Wide-field fundus image from infant ROP screening:
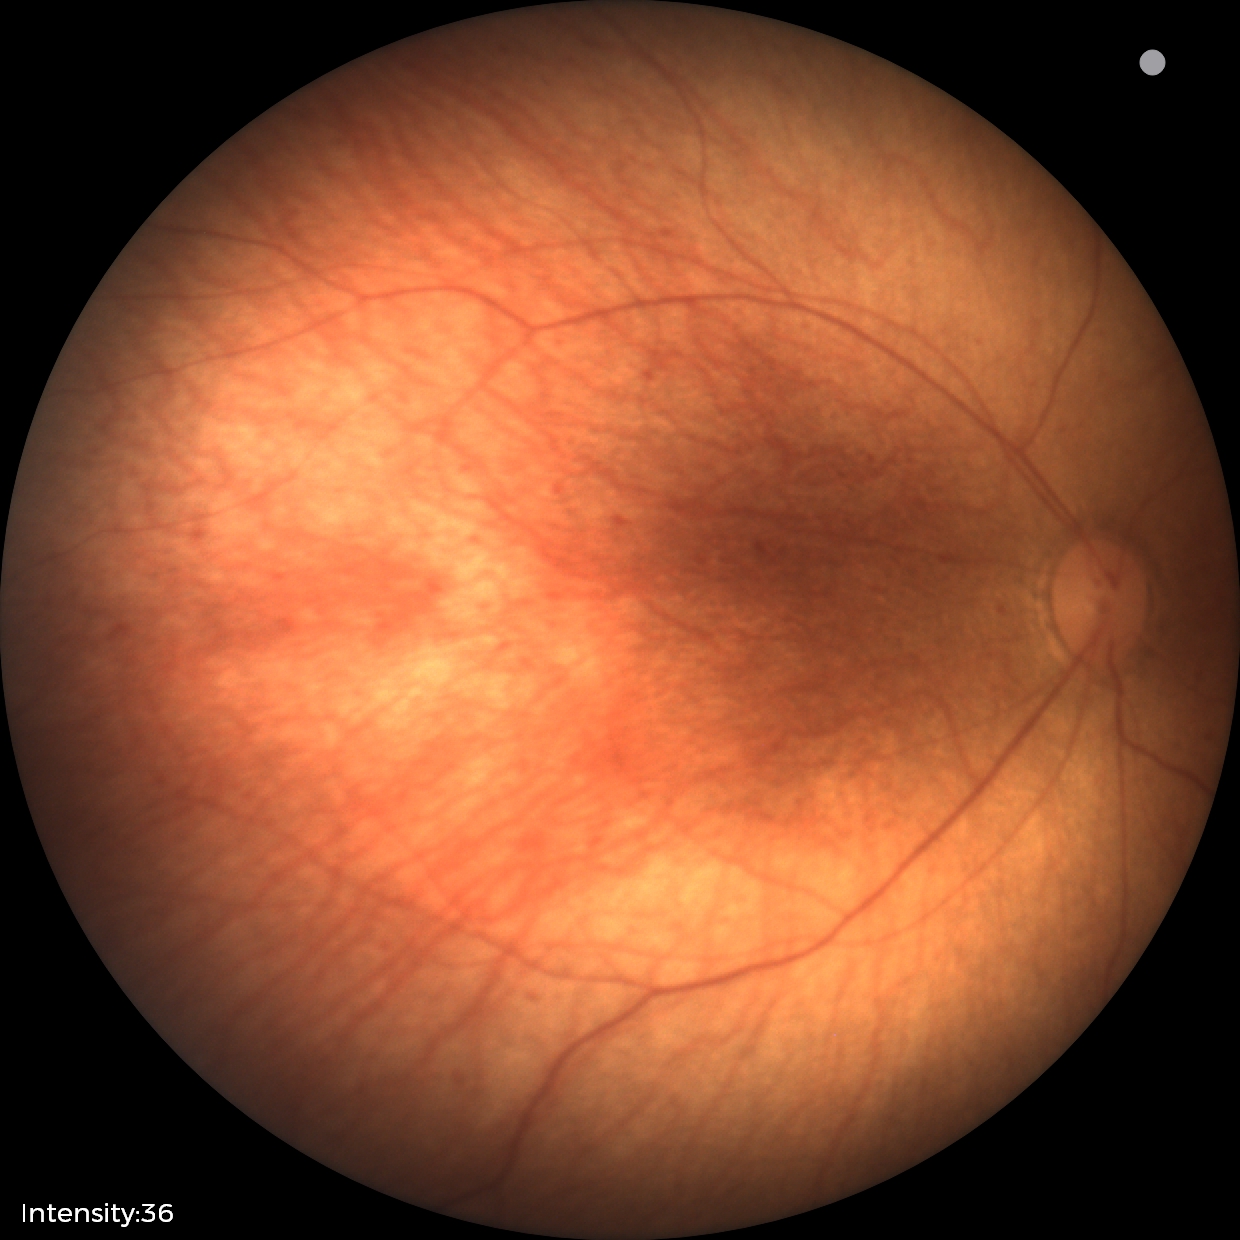
Q: What was the screening finding?
A: normal fundus examination